Without pupil dilation, Davis DR grading
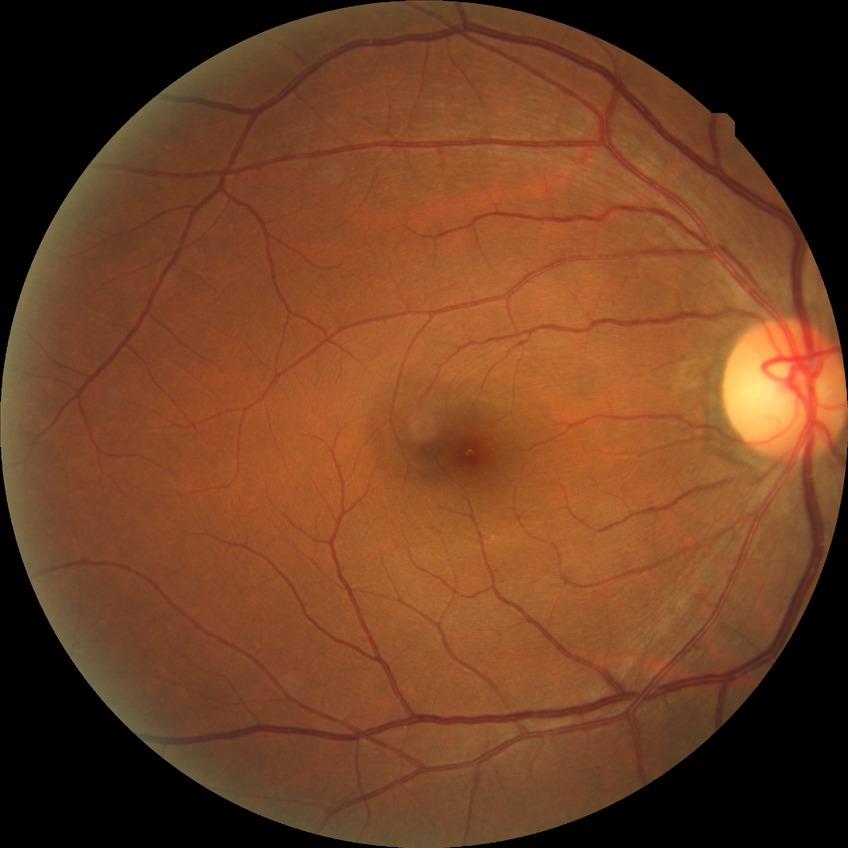 diabetic retinopathy (DR) = NDR (no diabetic retinopathy)